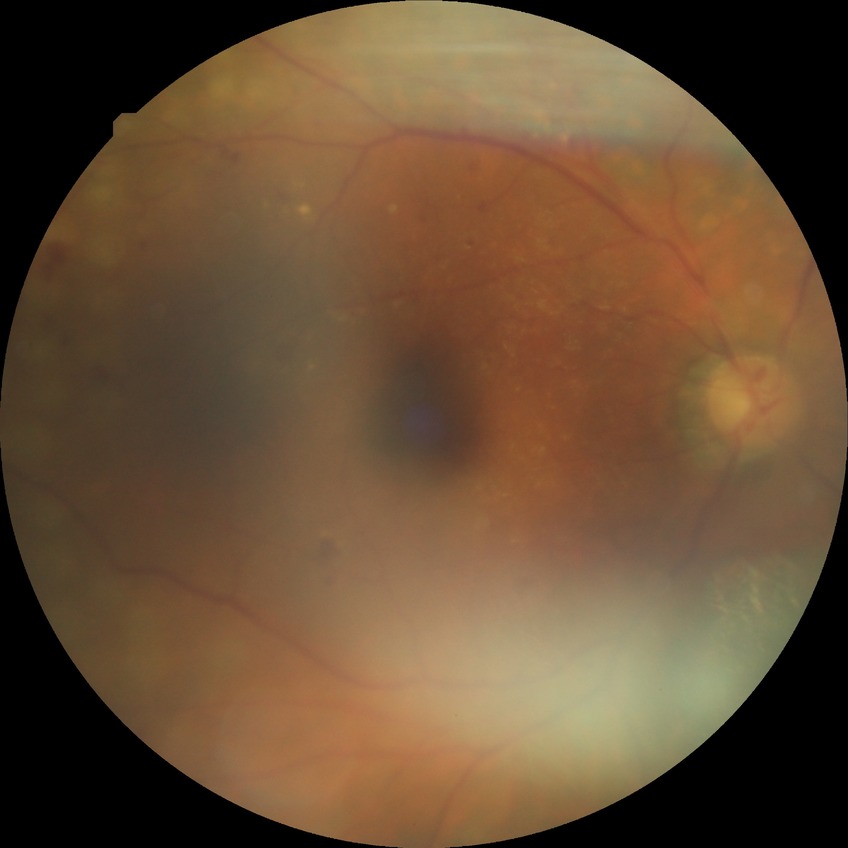
Diabetic retinopathy (DR): PDR (proliferative diabetic retinopathy).